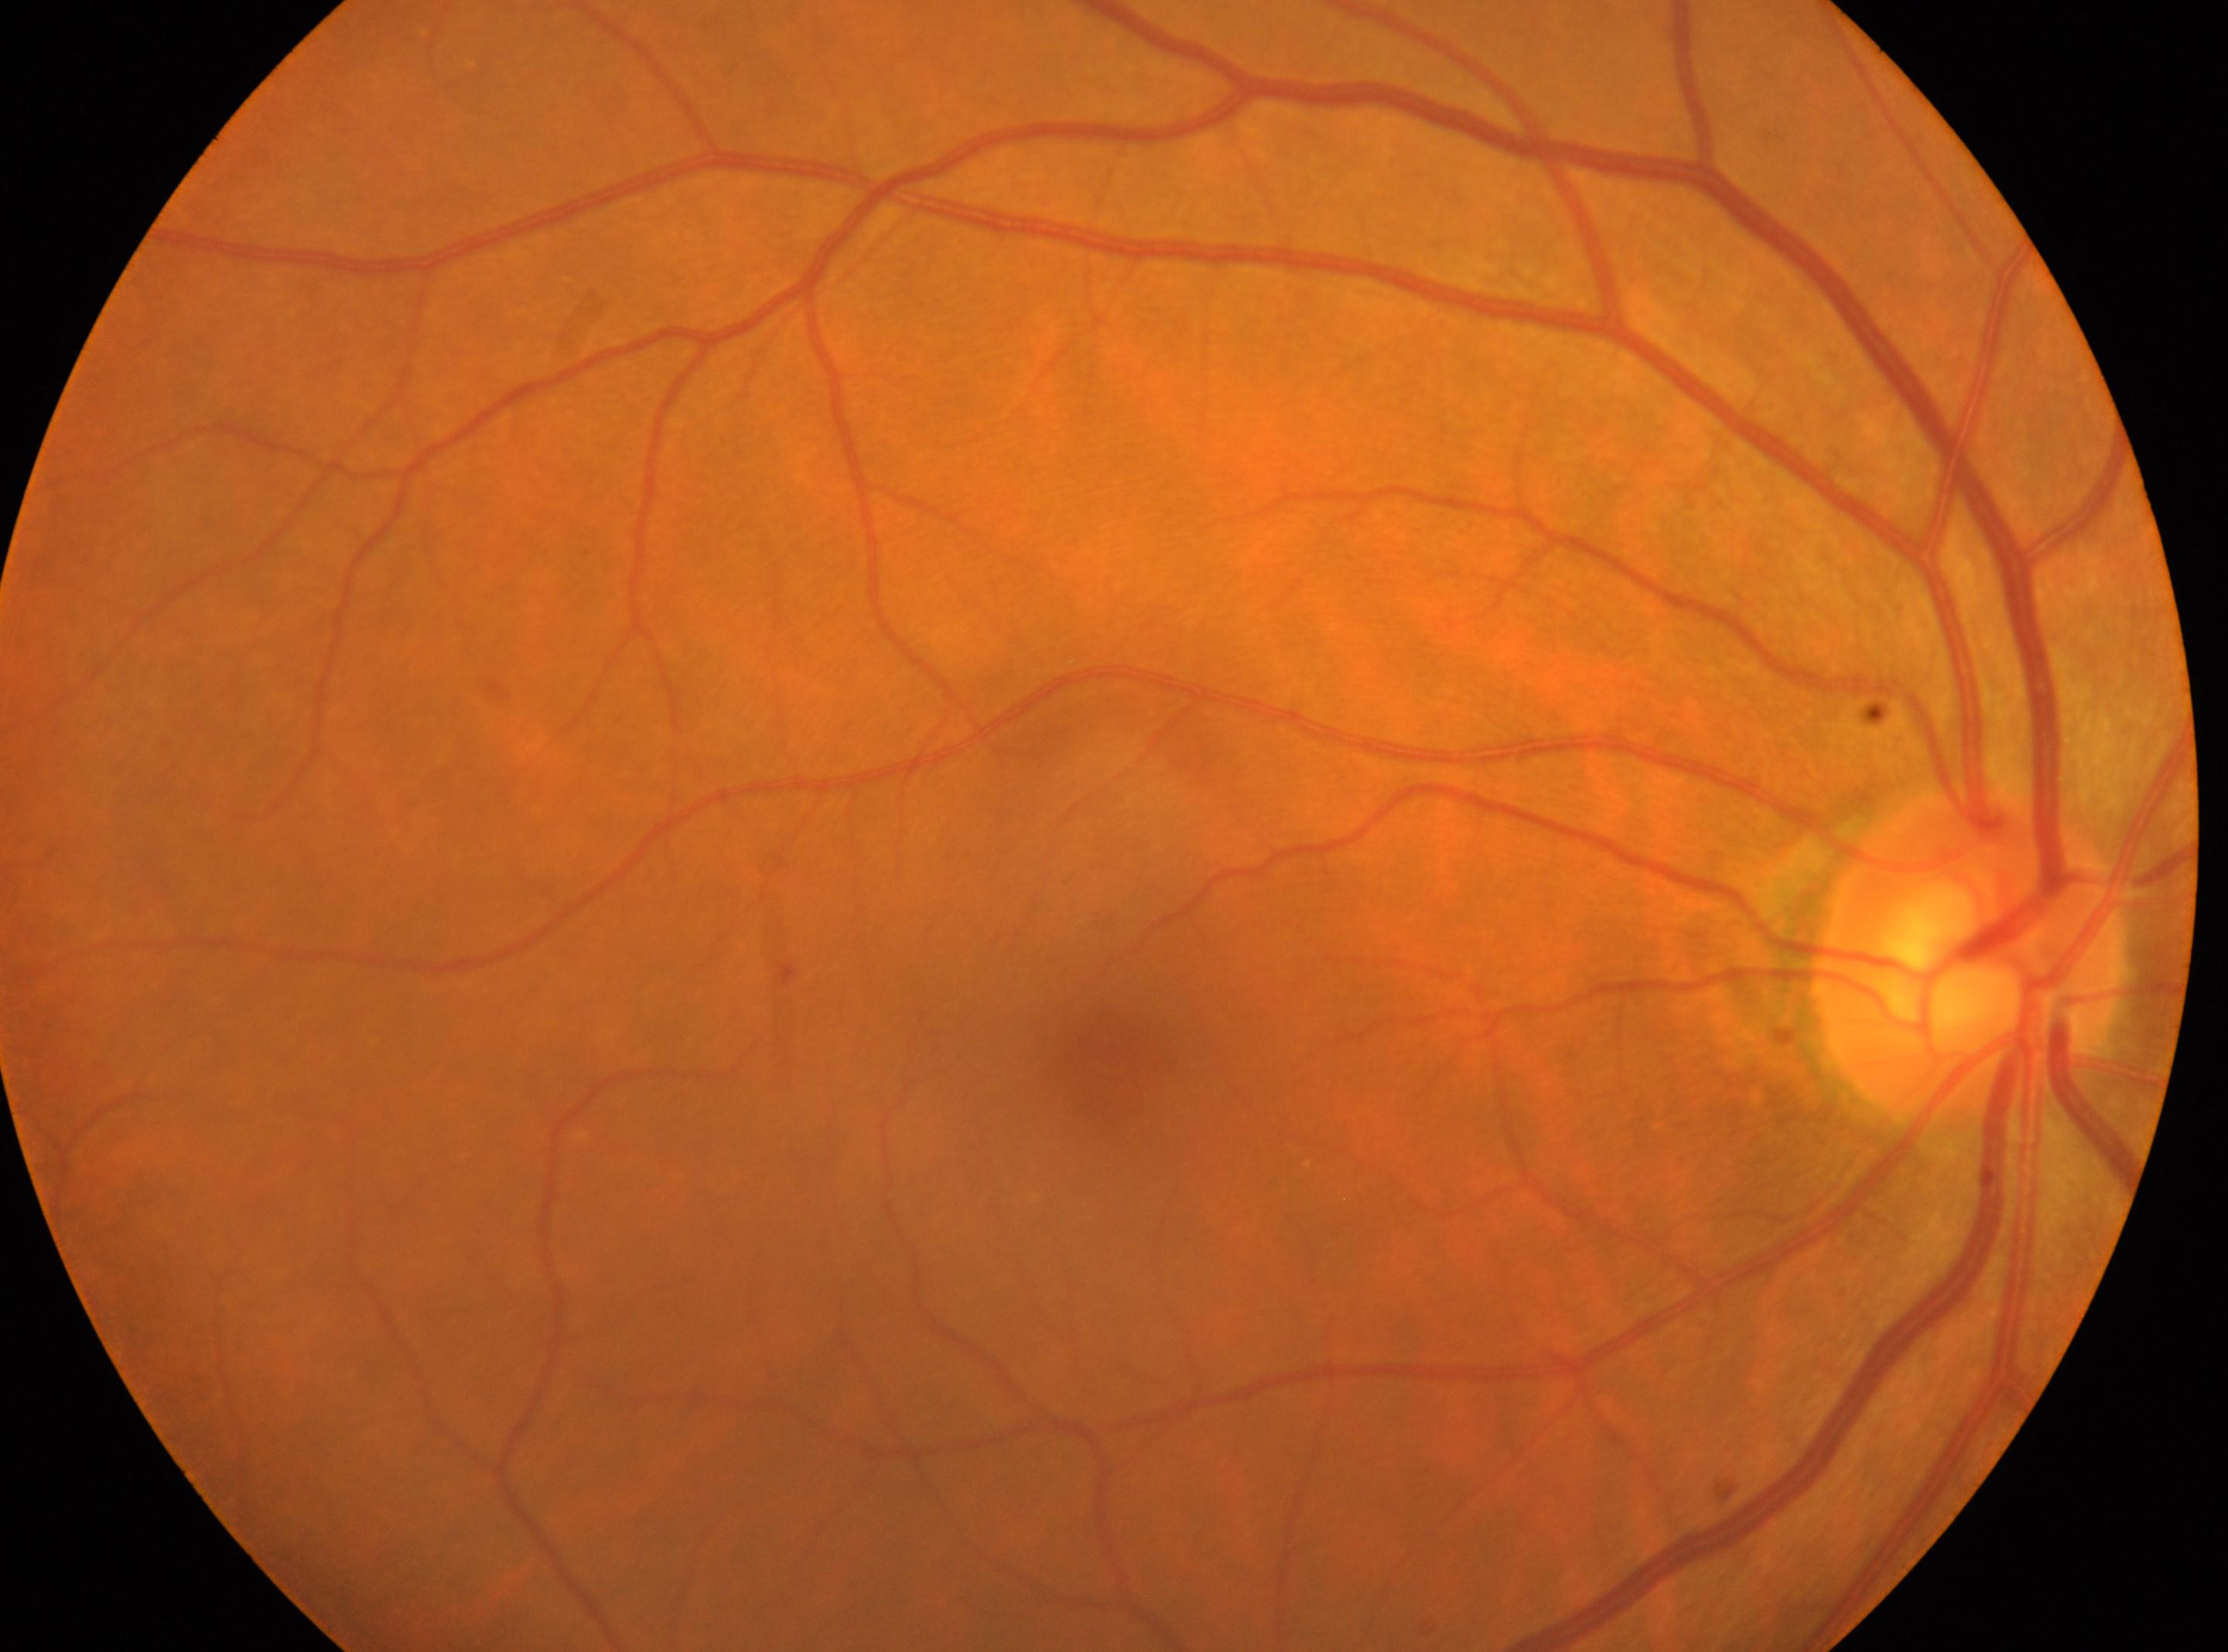

DR class: non-proliferative diabetic retinopathy.
Optic disk: (x: 1967, y: 956).
The image shows the right eye.
Macular center located at (x: 1109, y: 1055).
DR grade is 1.